45-degree field of view · color fundus image: 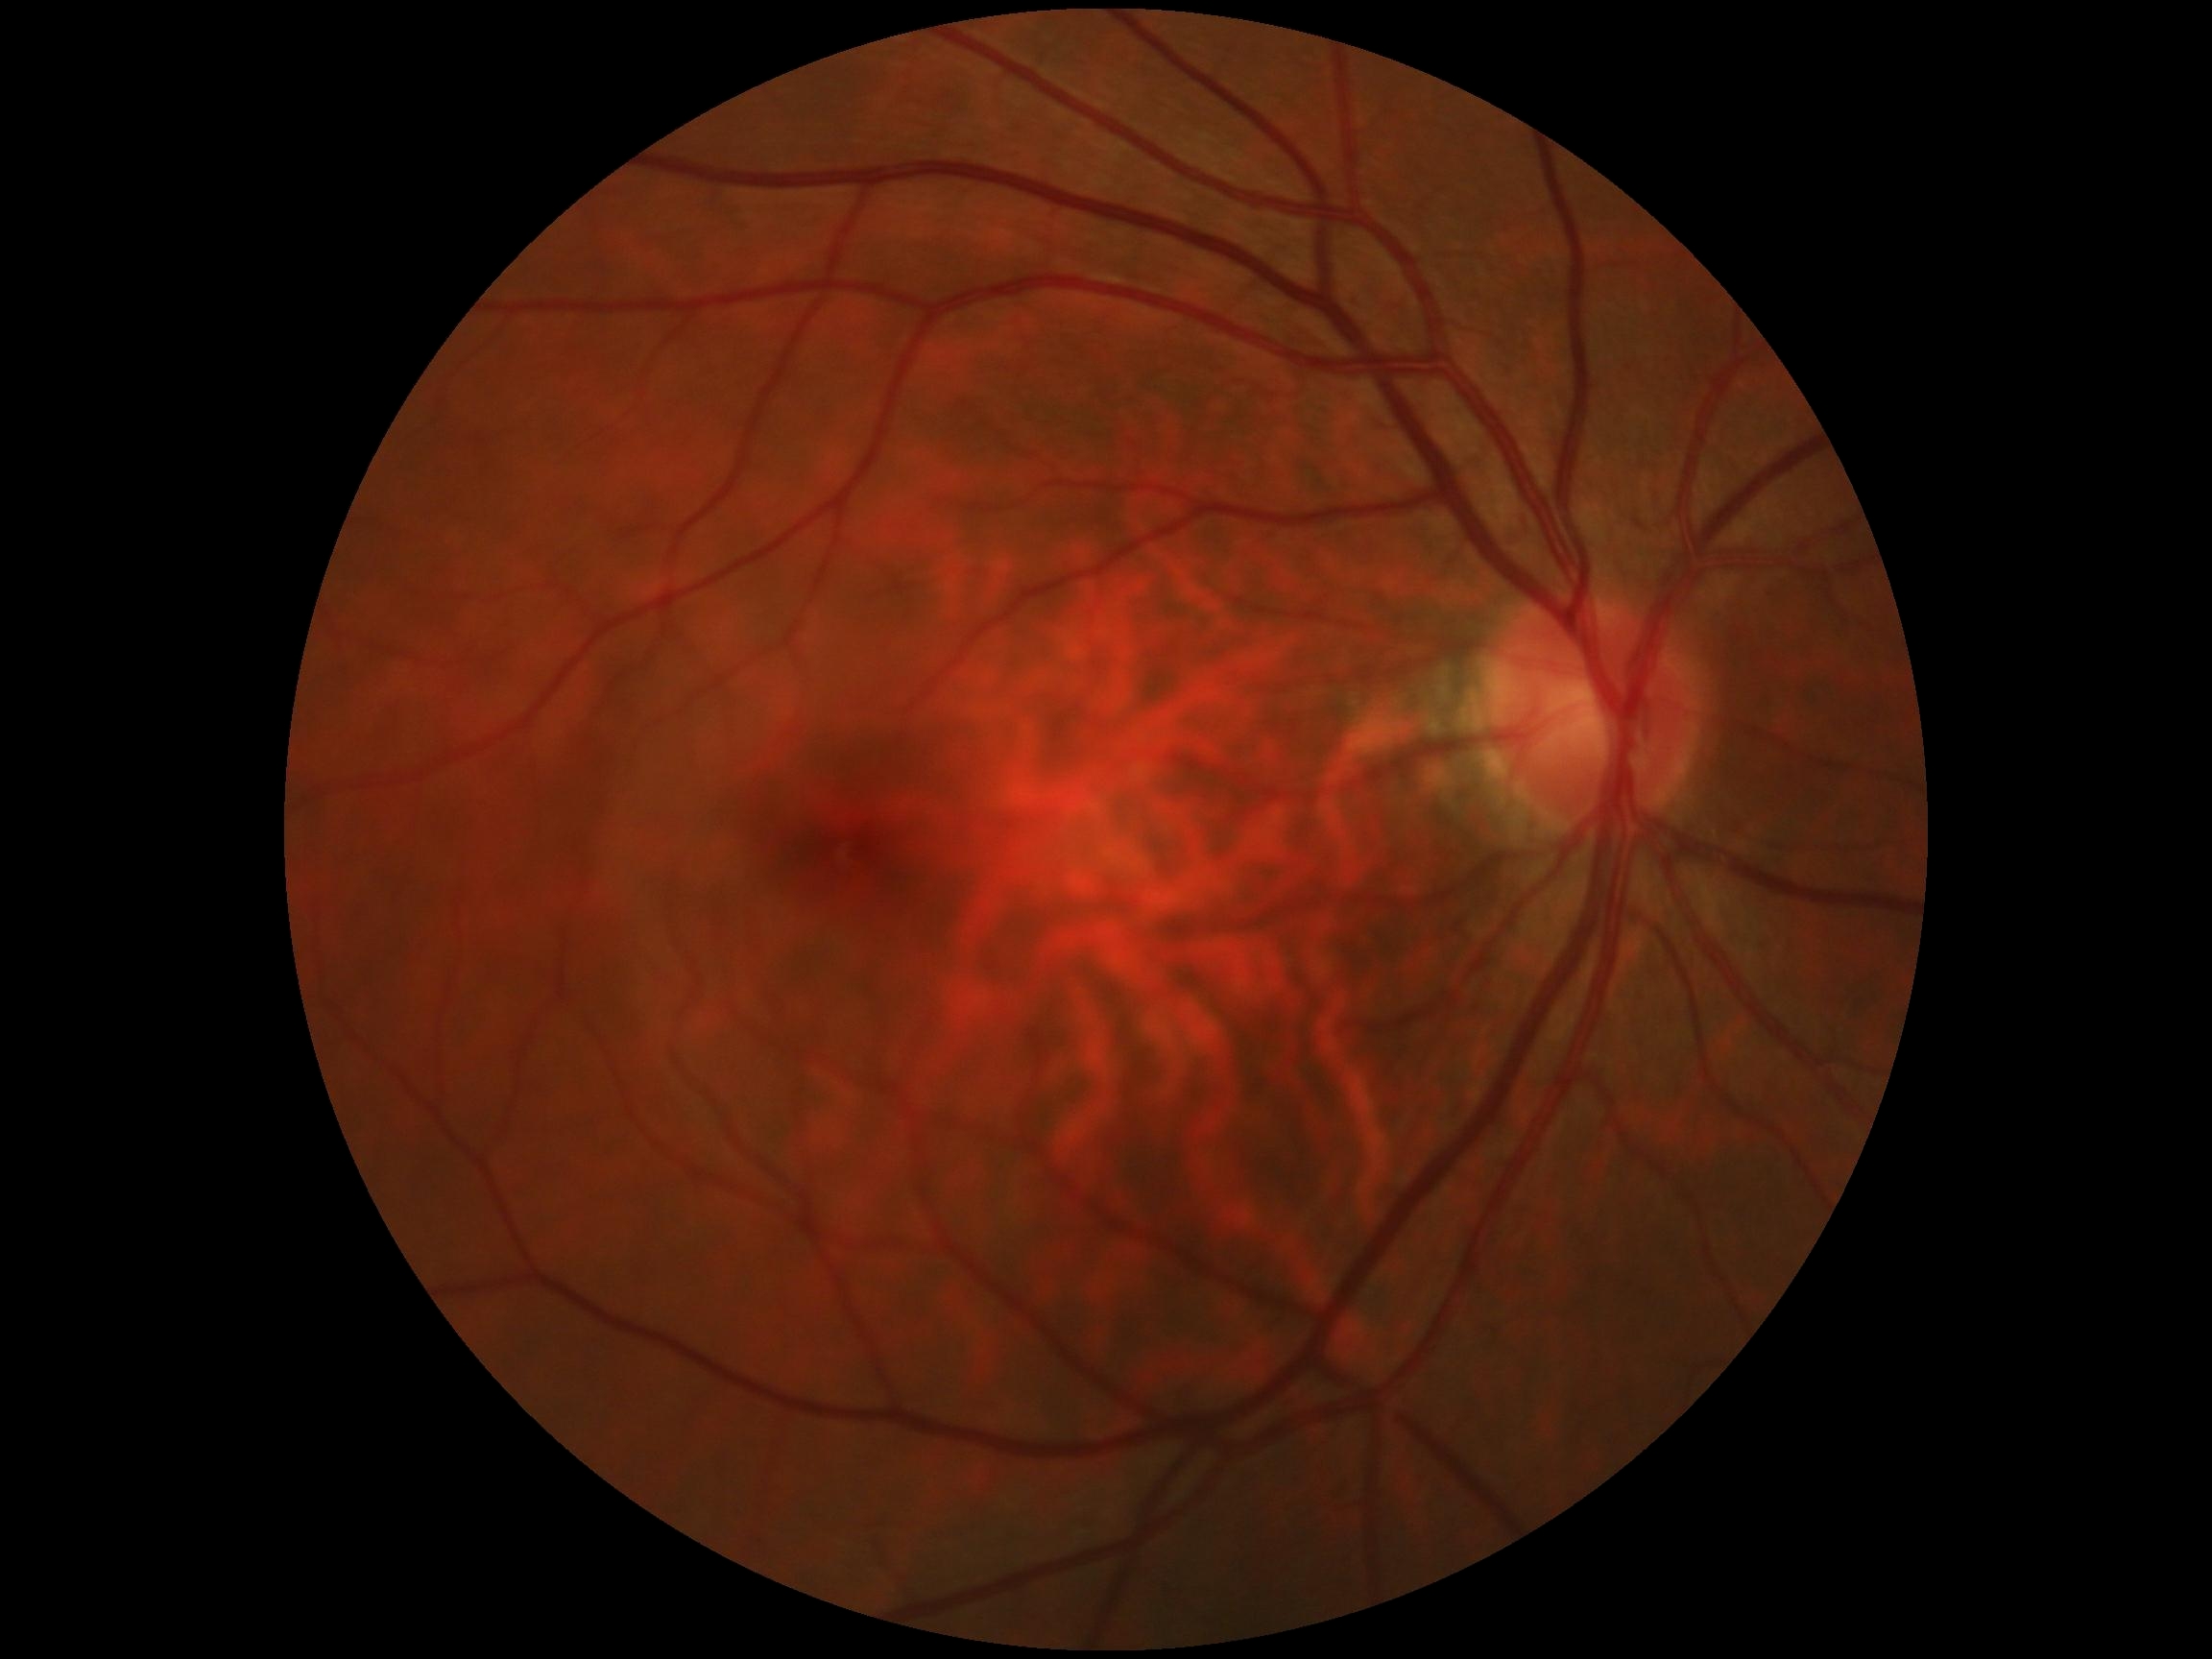 DR grade: 0 (no apparent retinopathy).